Retinal fundus photograph. Image size 2352x1568. 45-degree field of view
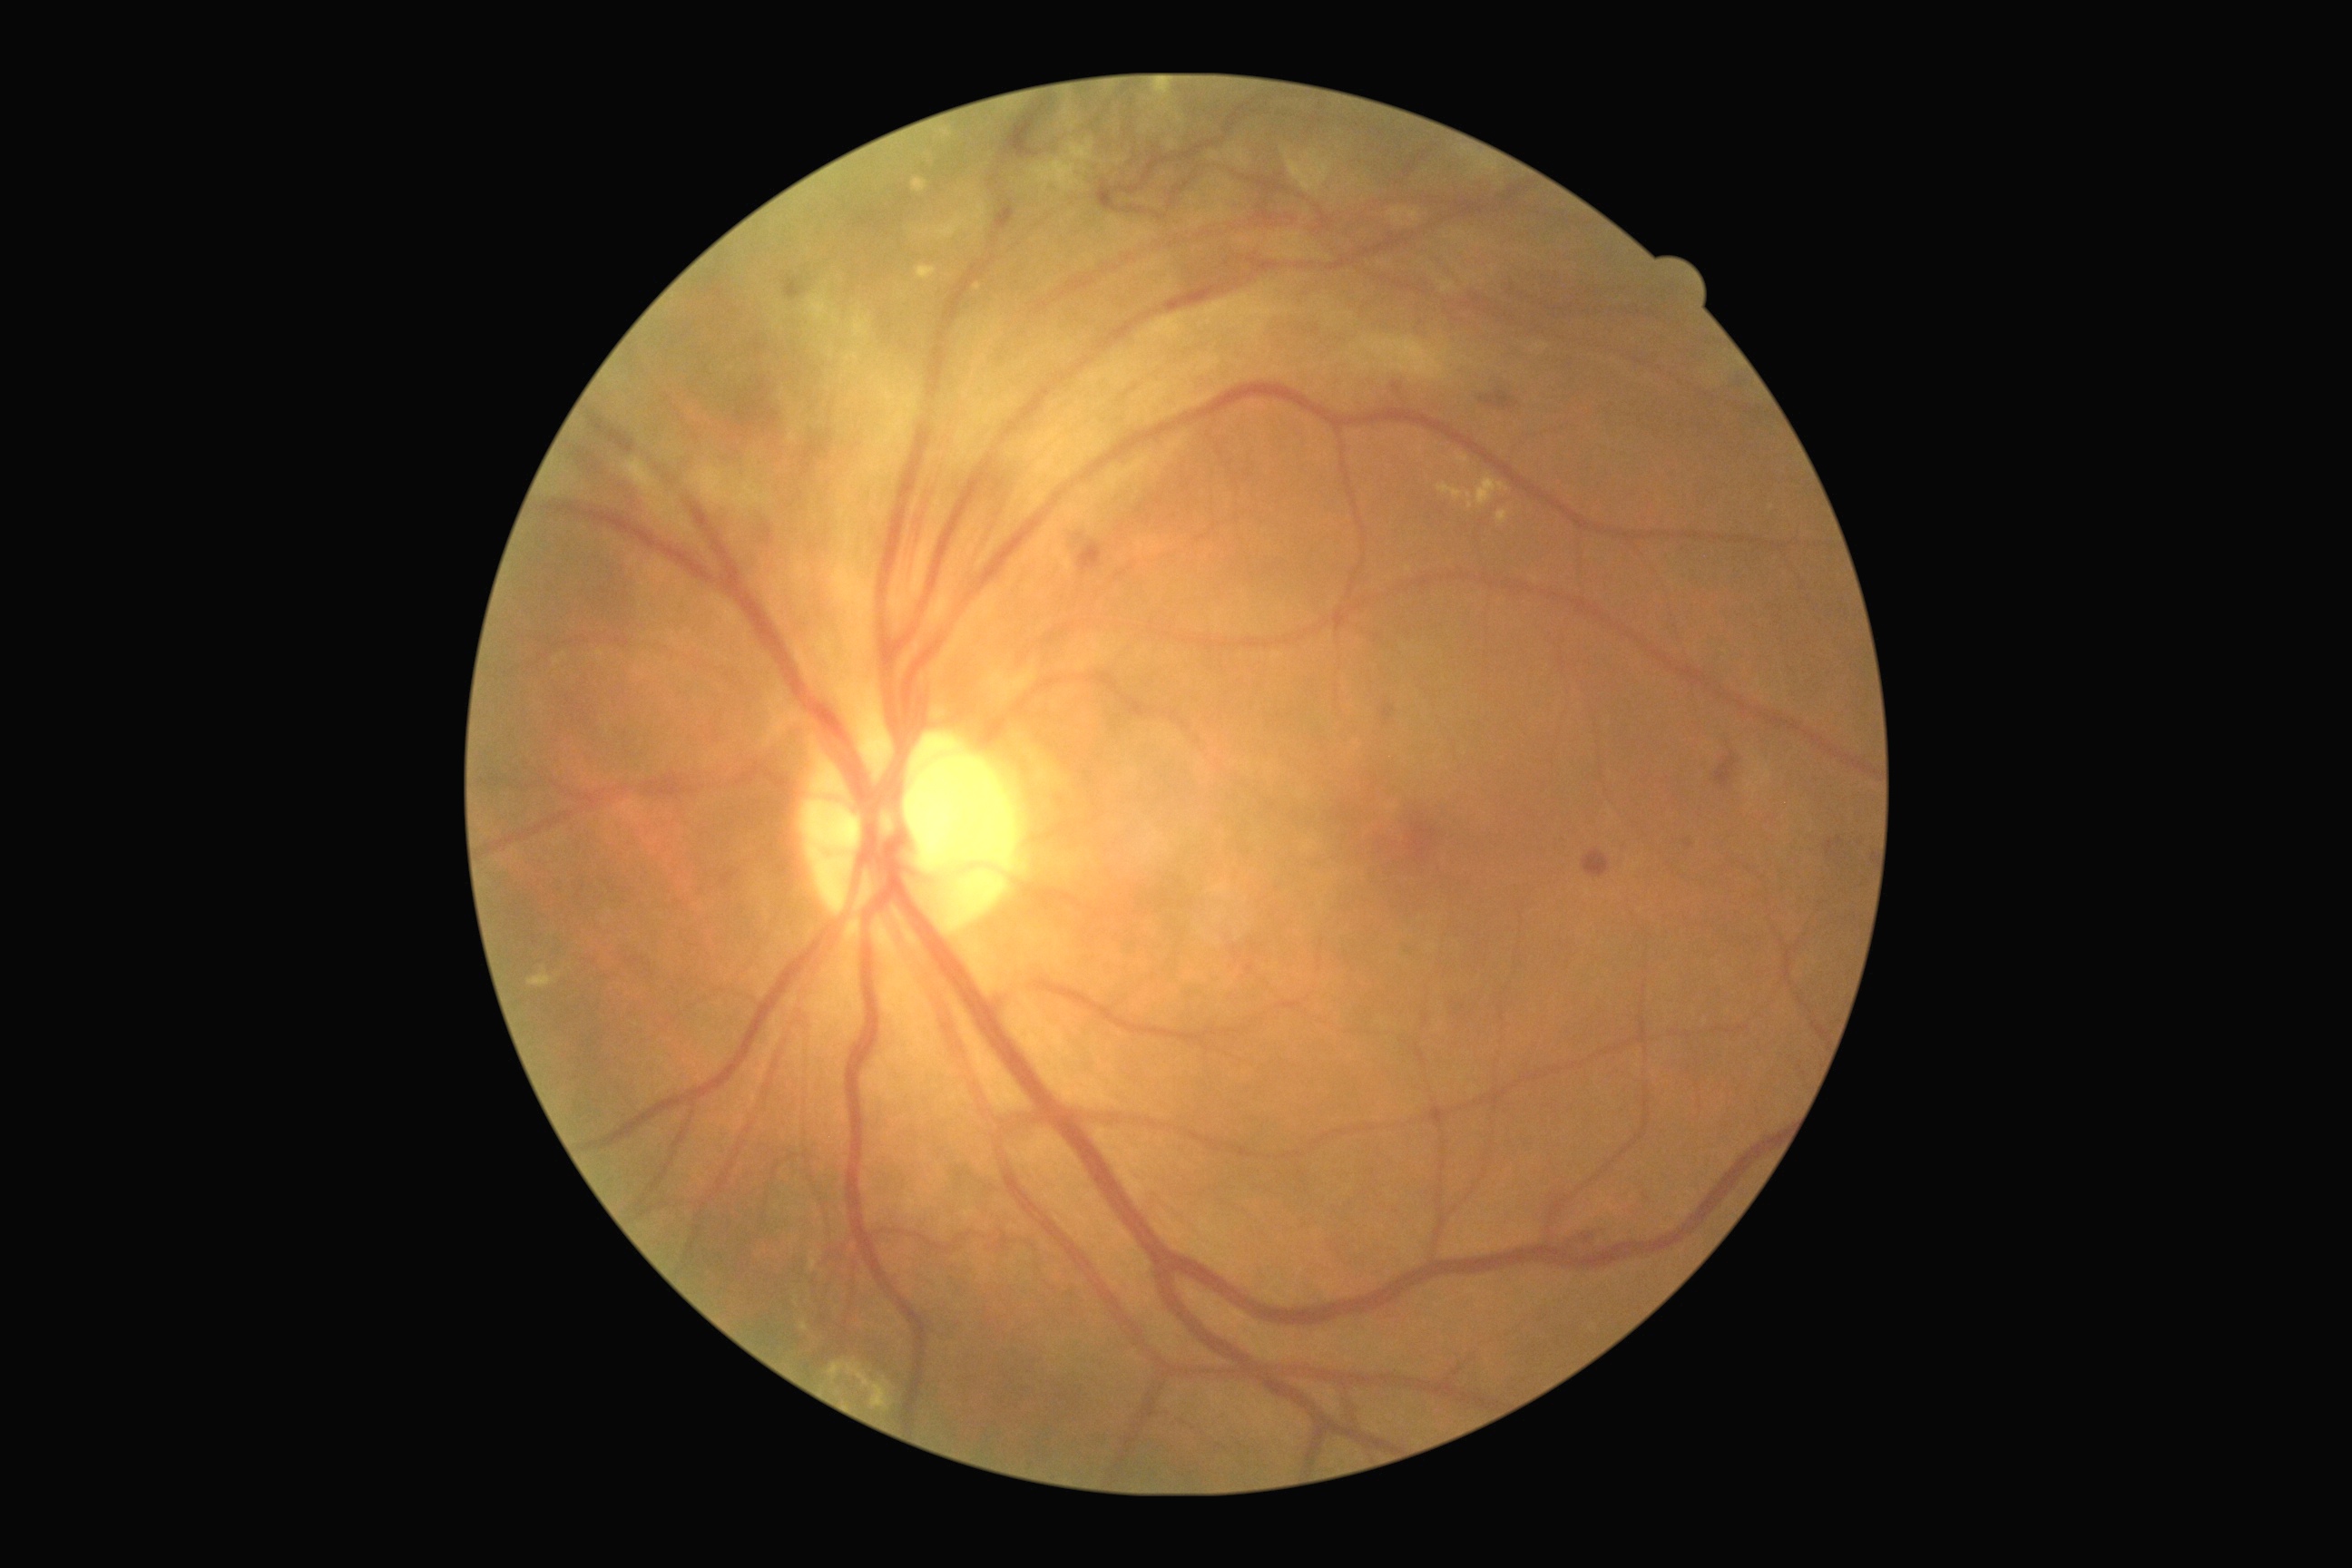

Findings:
• retinopathy grade: 4 (PDR) — neovascularization and/or vitreous/pre-retinal hemorrhage